Image size 848x848
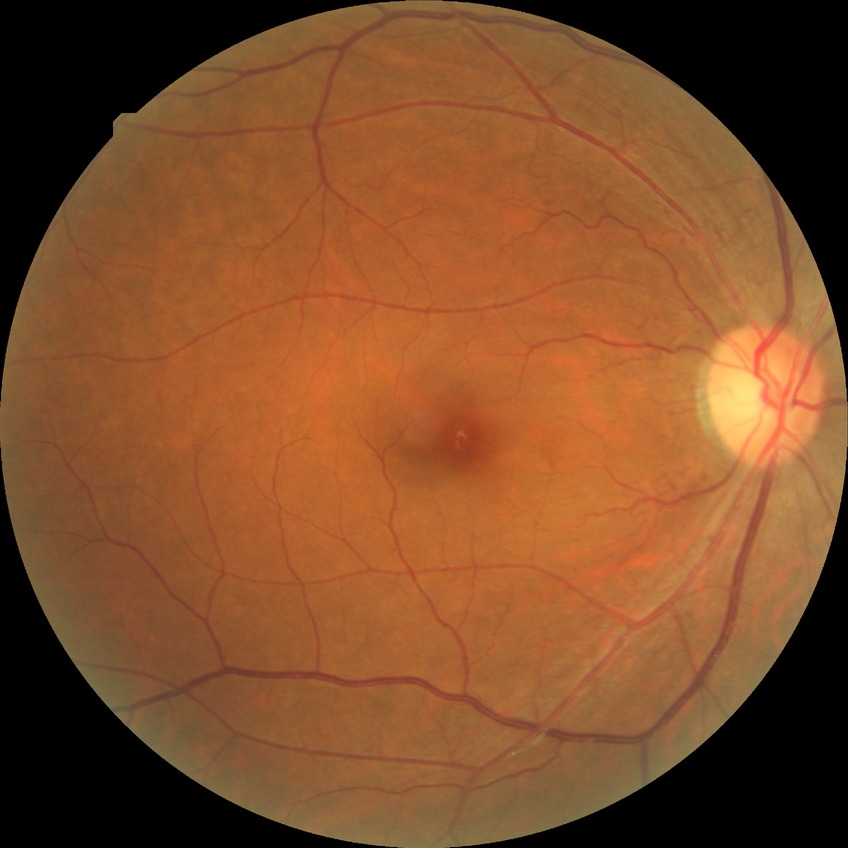
DR stage: NDR; DR impression: no apparent DR.